1932x1932 — 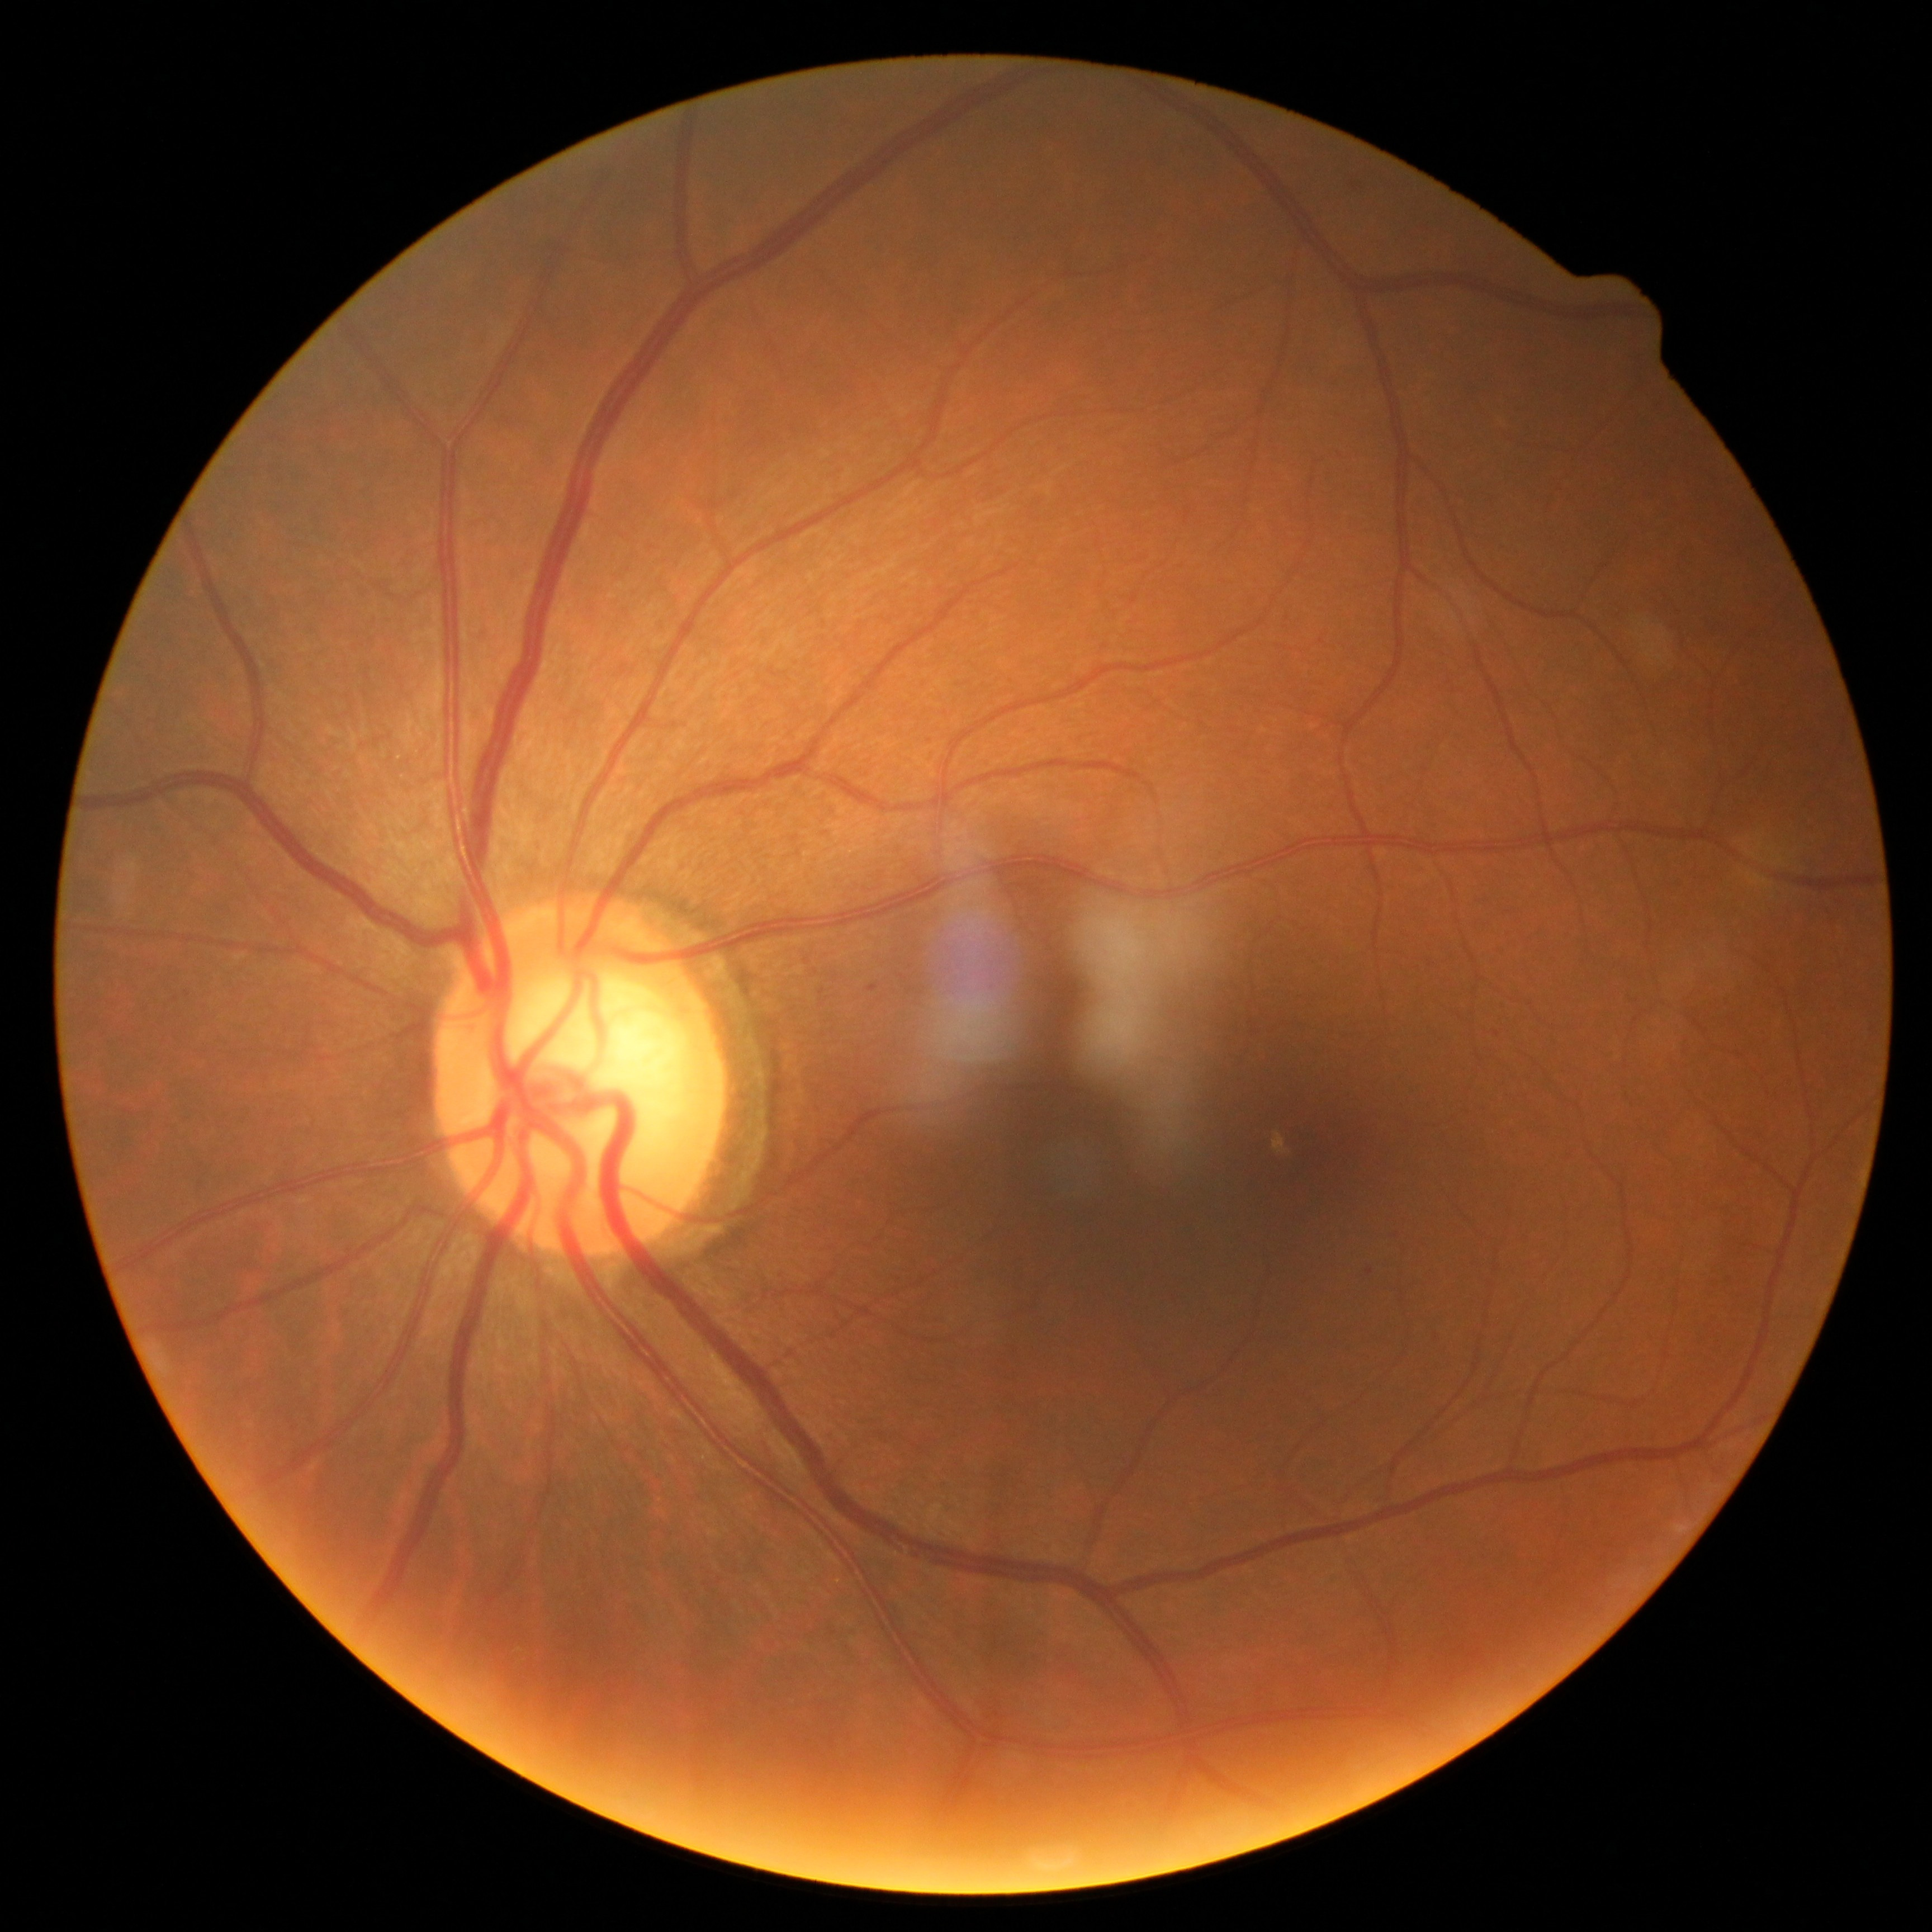 {
  "dr_category": "non-proliferative diabetic retinopathy",
  "dr_grade": "1"
}